130° field of view (Clarity RetCam 3). Wide-field fundus photograph from neonatal ROP screening:
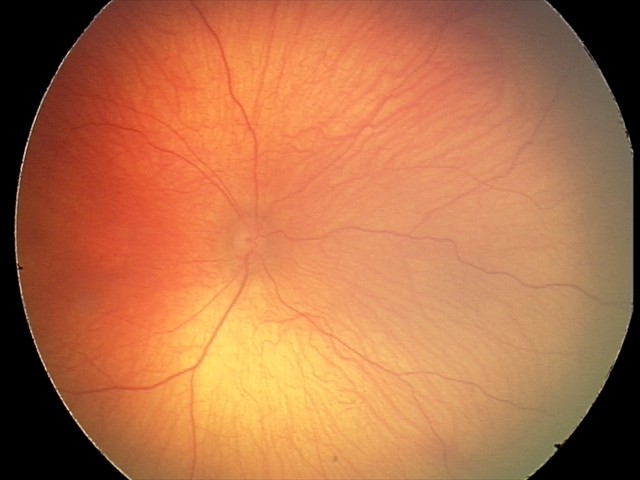
Screening examination with no abnormal retinal findings.